Infant wide-field fundus photograph. Camera: Phoenix ICON (100° FOV). 1240x1240px:
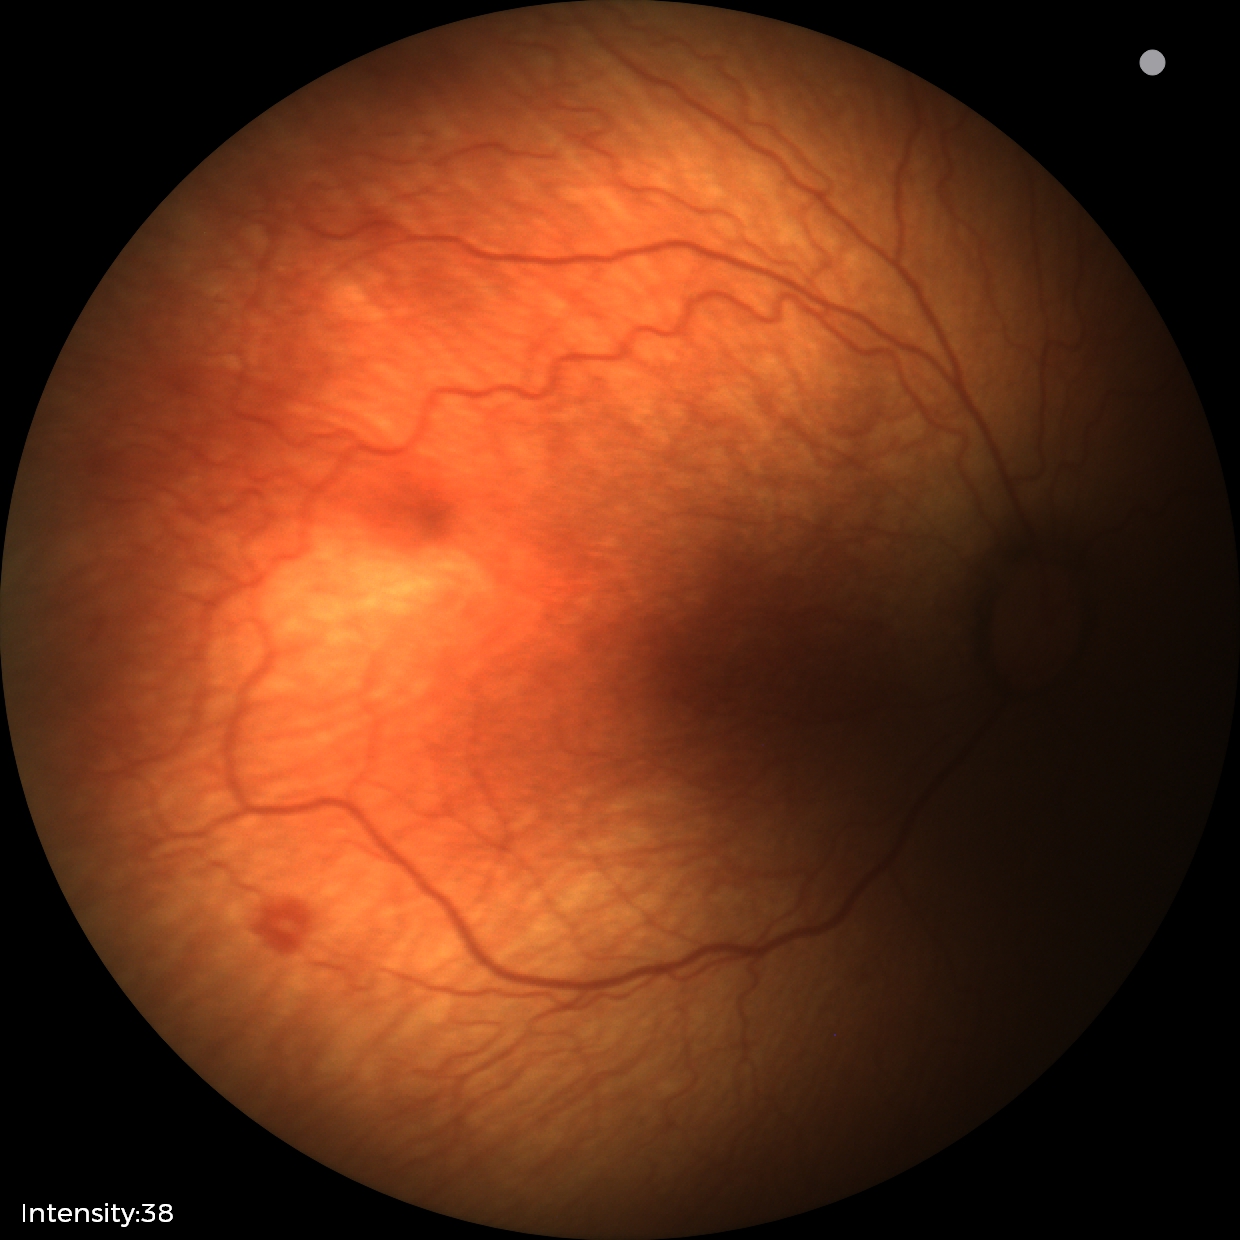

Plus form: absent, ROP stage: 1 — demarcation line between vascular and avascular retina.